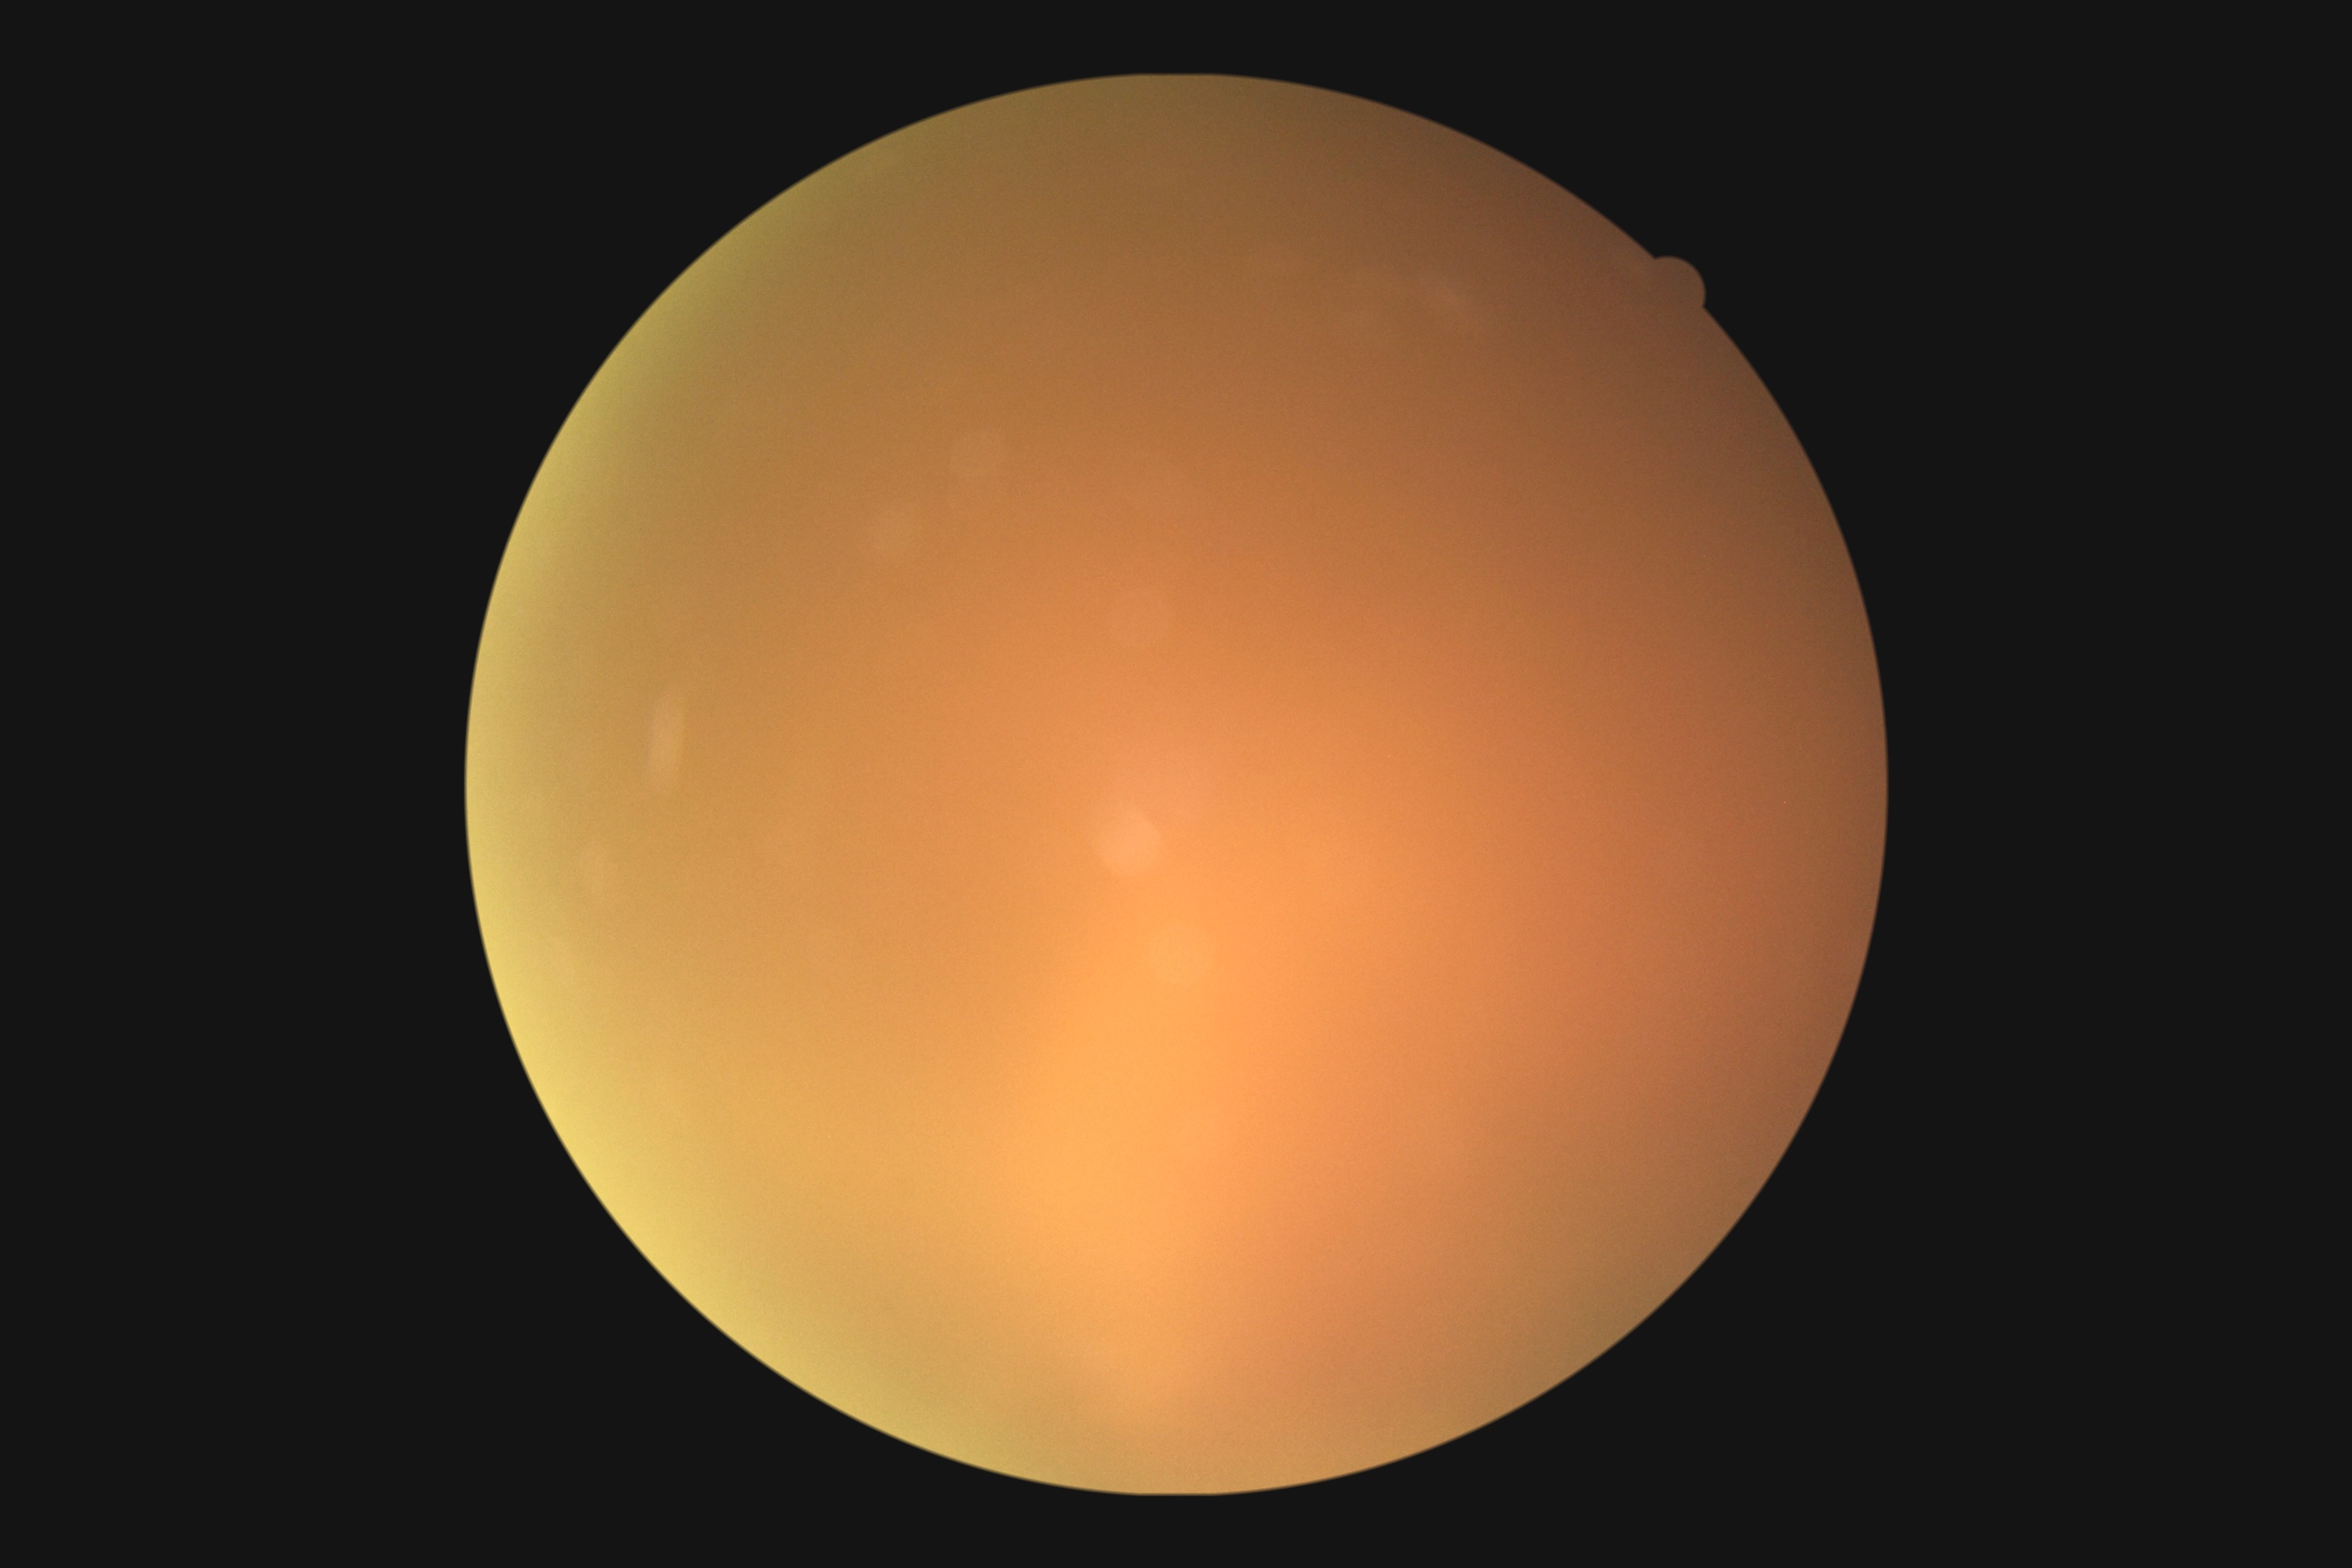

Diabetic retinopathy severity is ungradable due to poor image quality.
Ungradable image — DR severity cannot be determined.